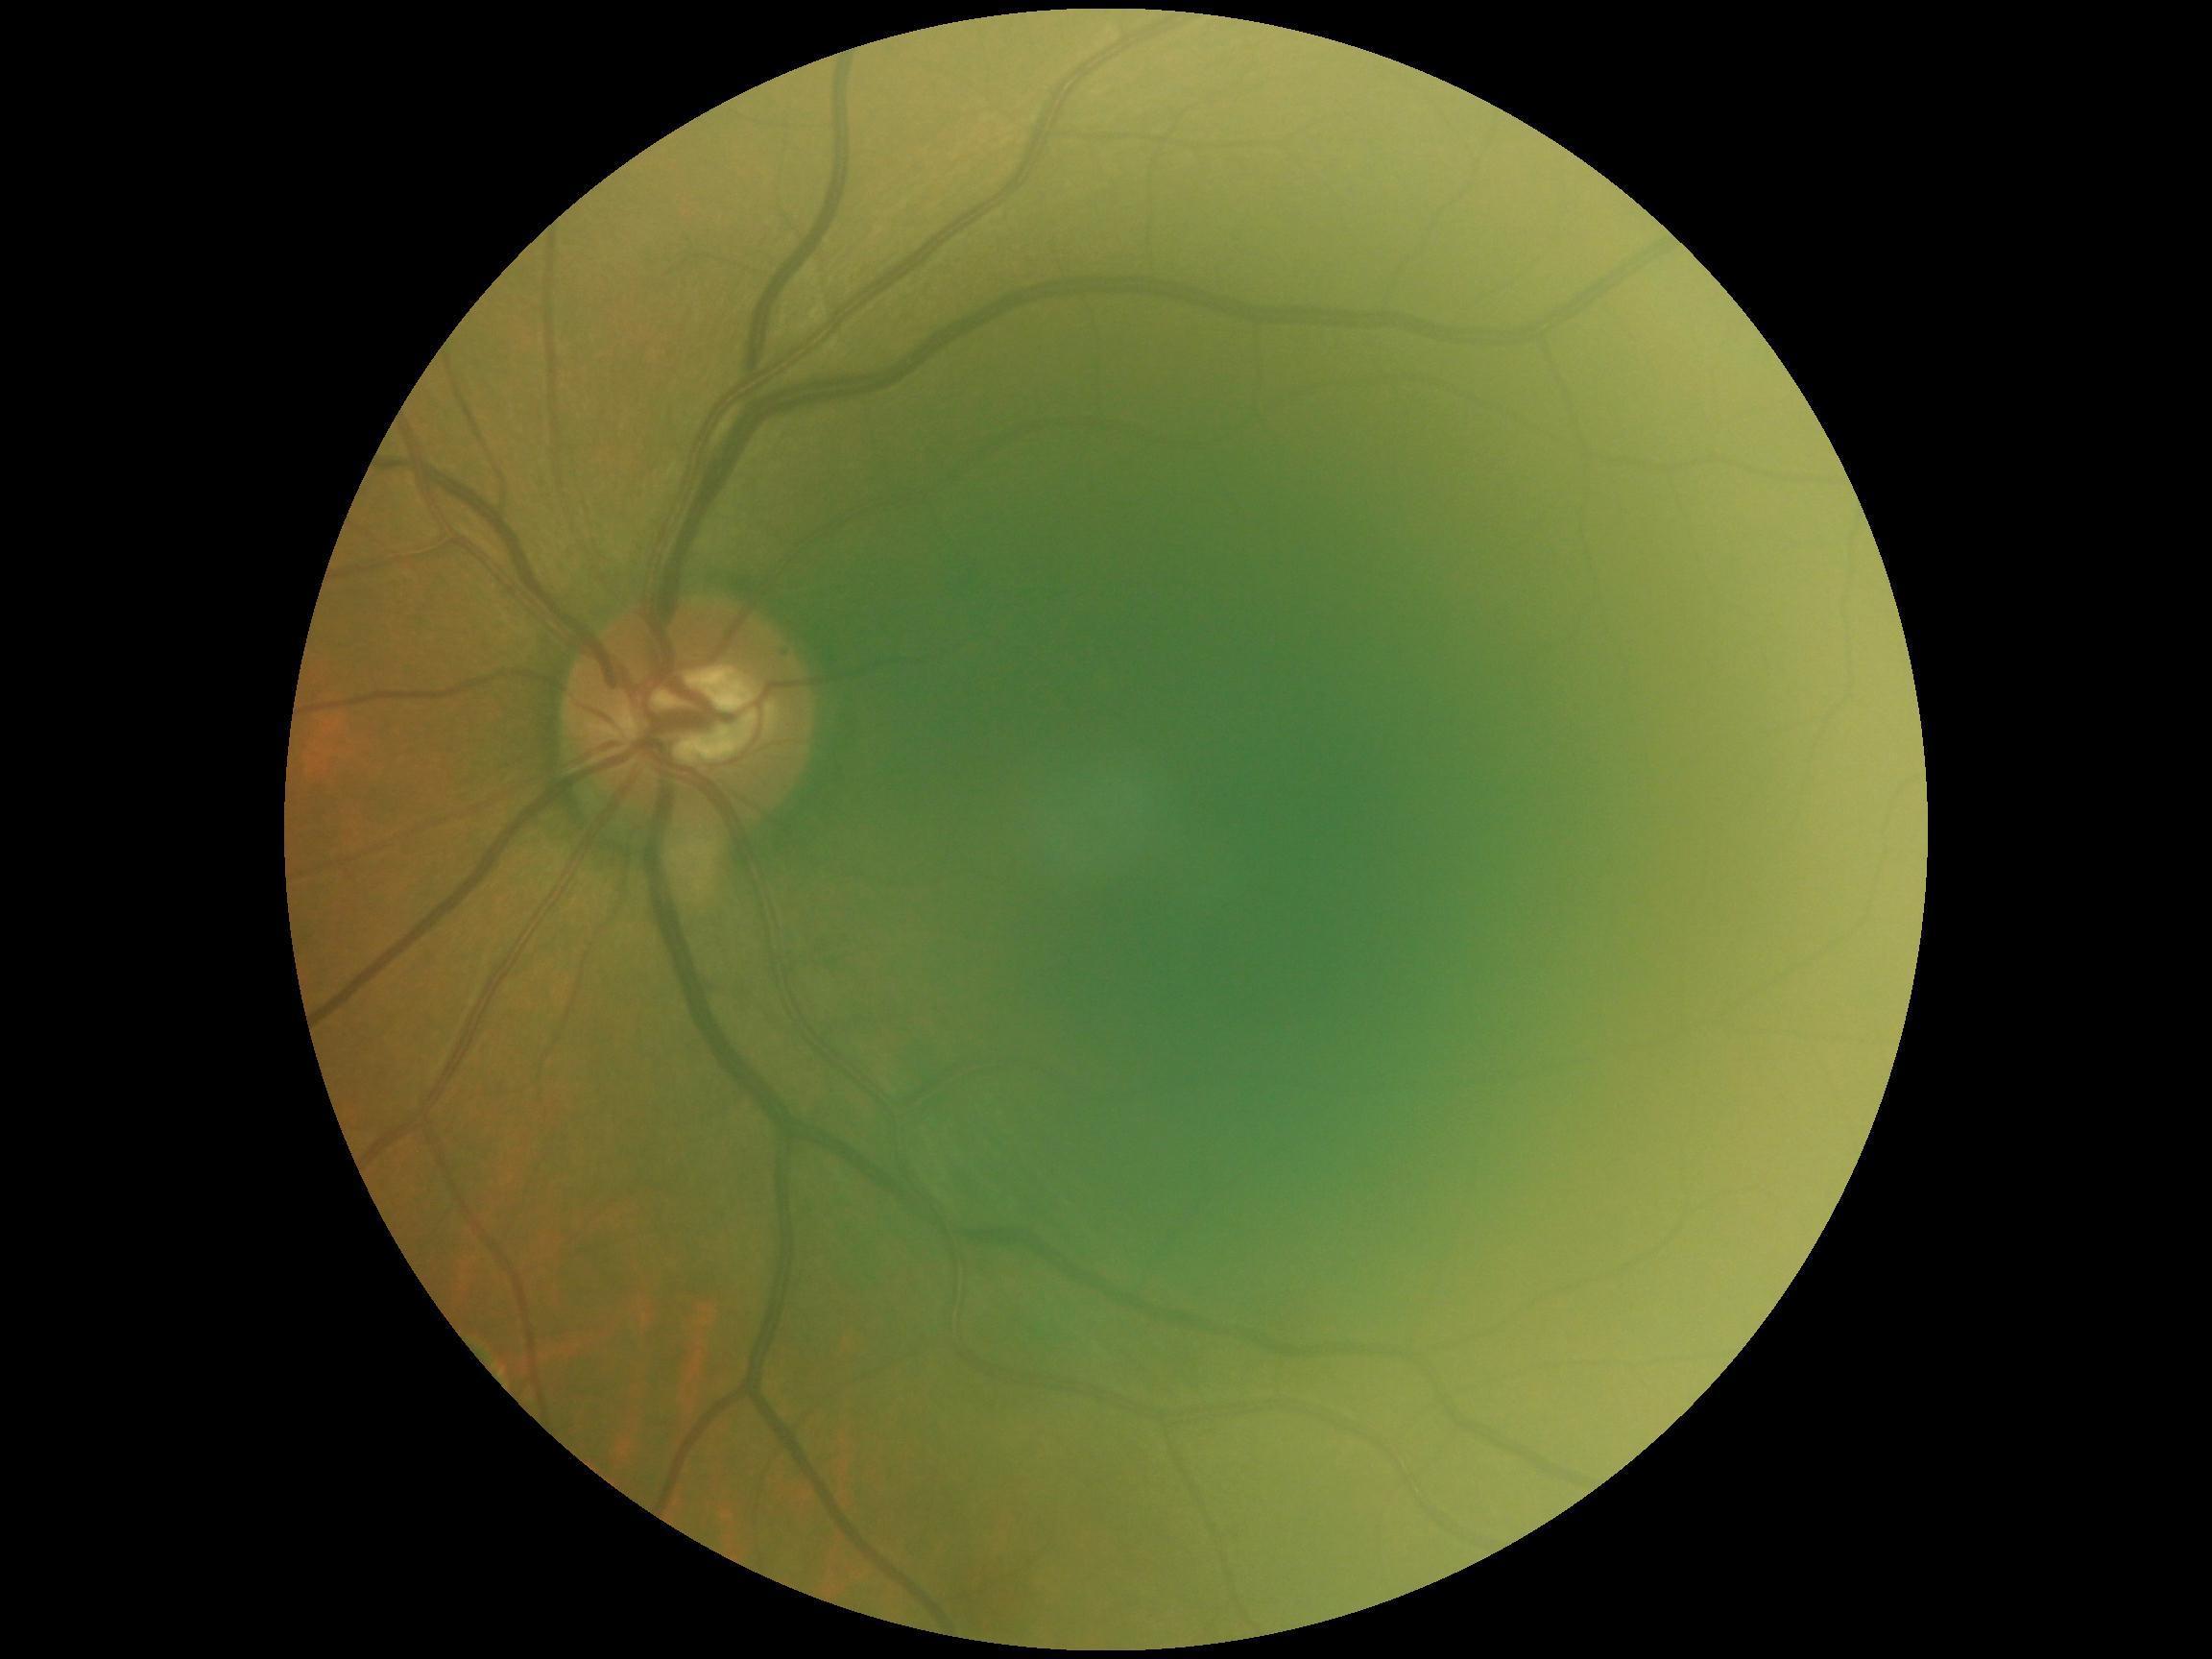 DR severity = no apparent diabetic retinopathy (grade 0) — no visible signs of diabetic retinopathy